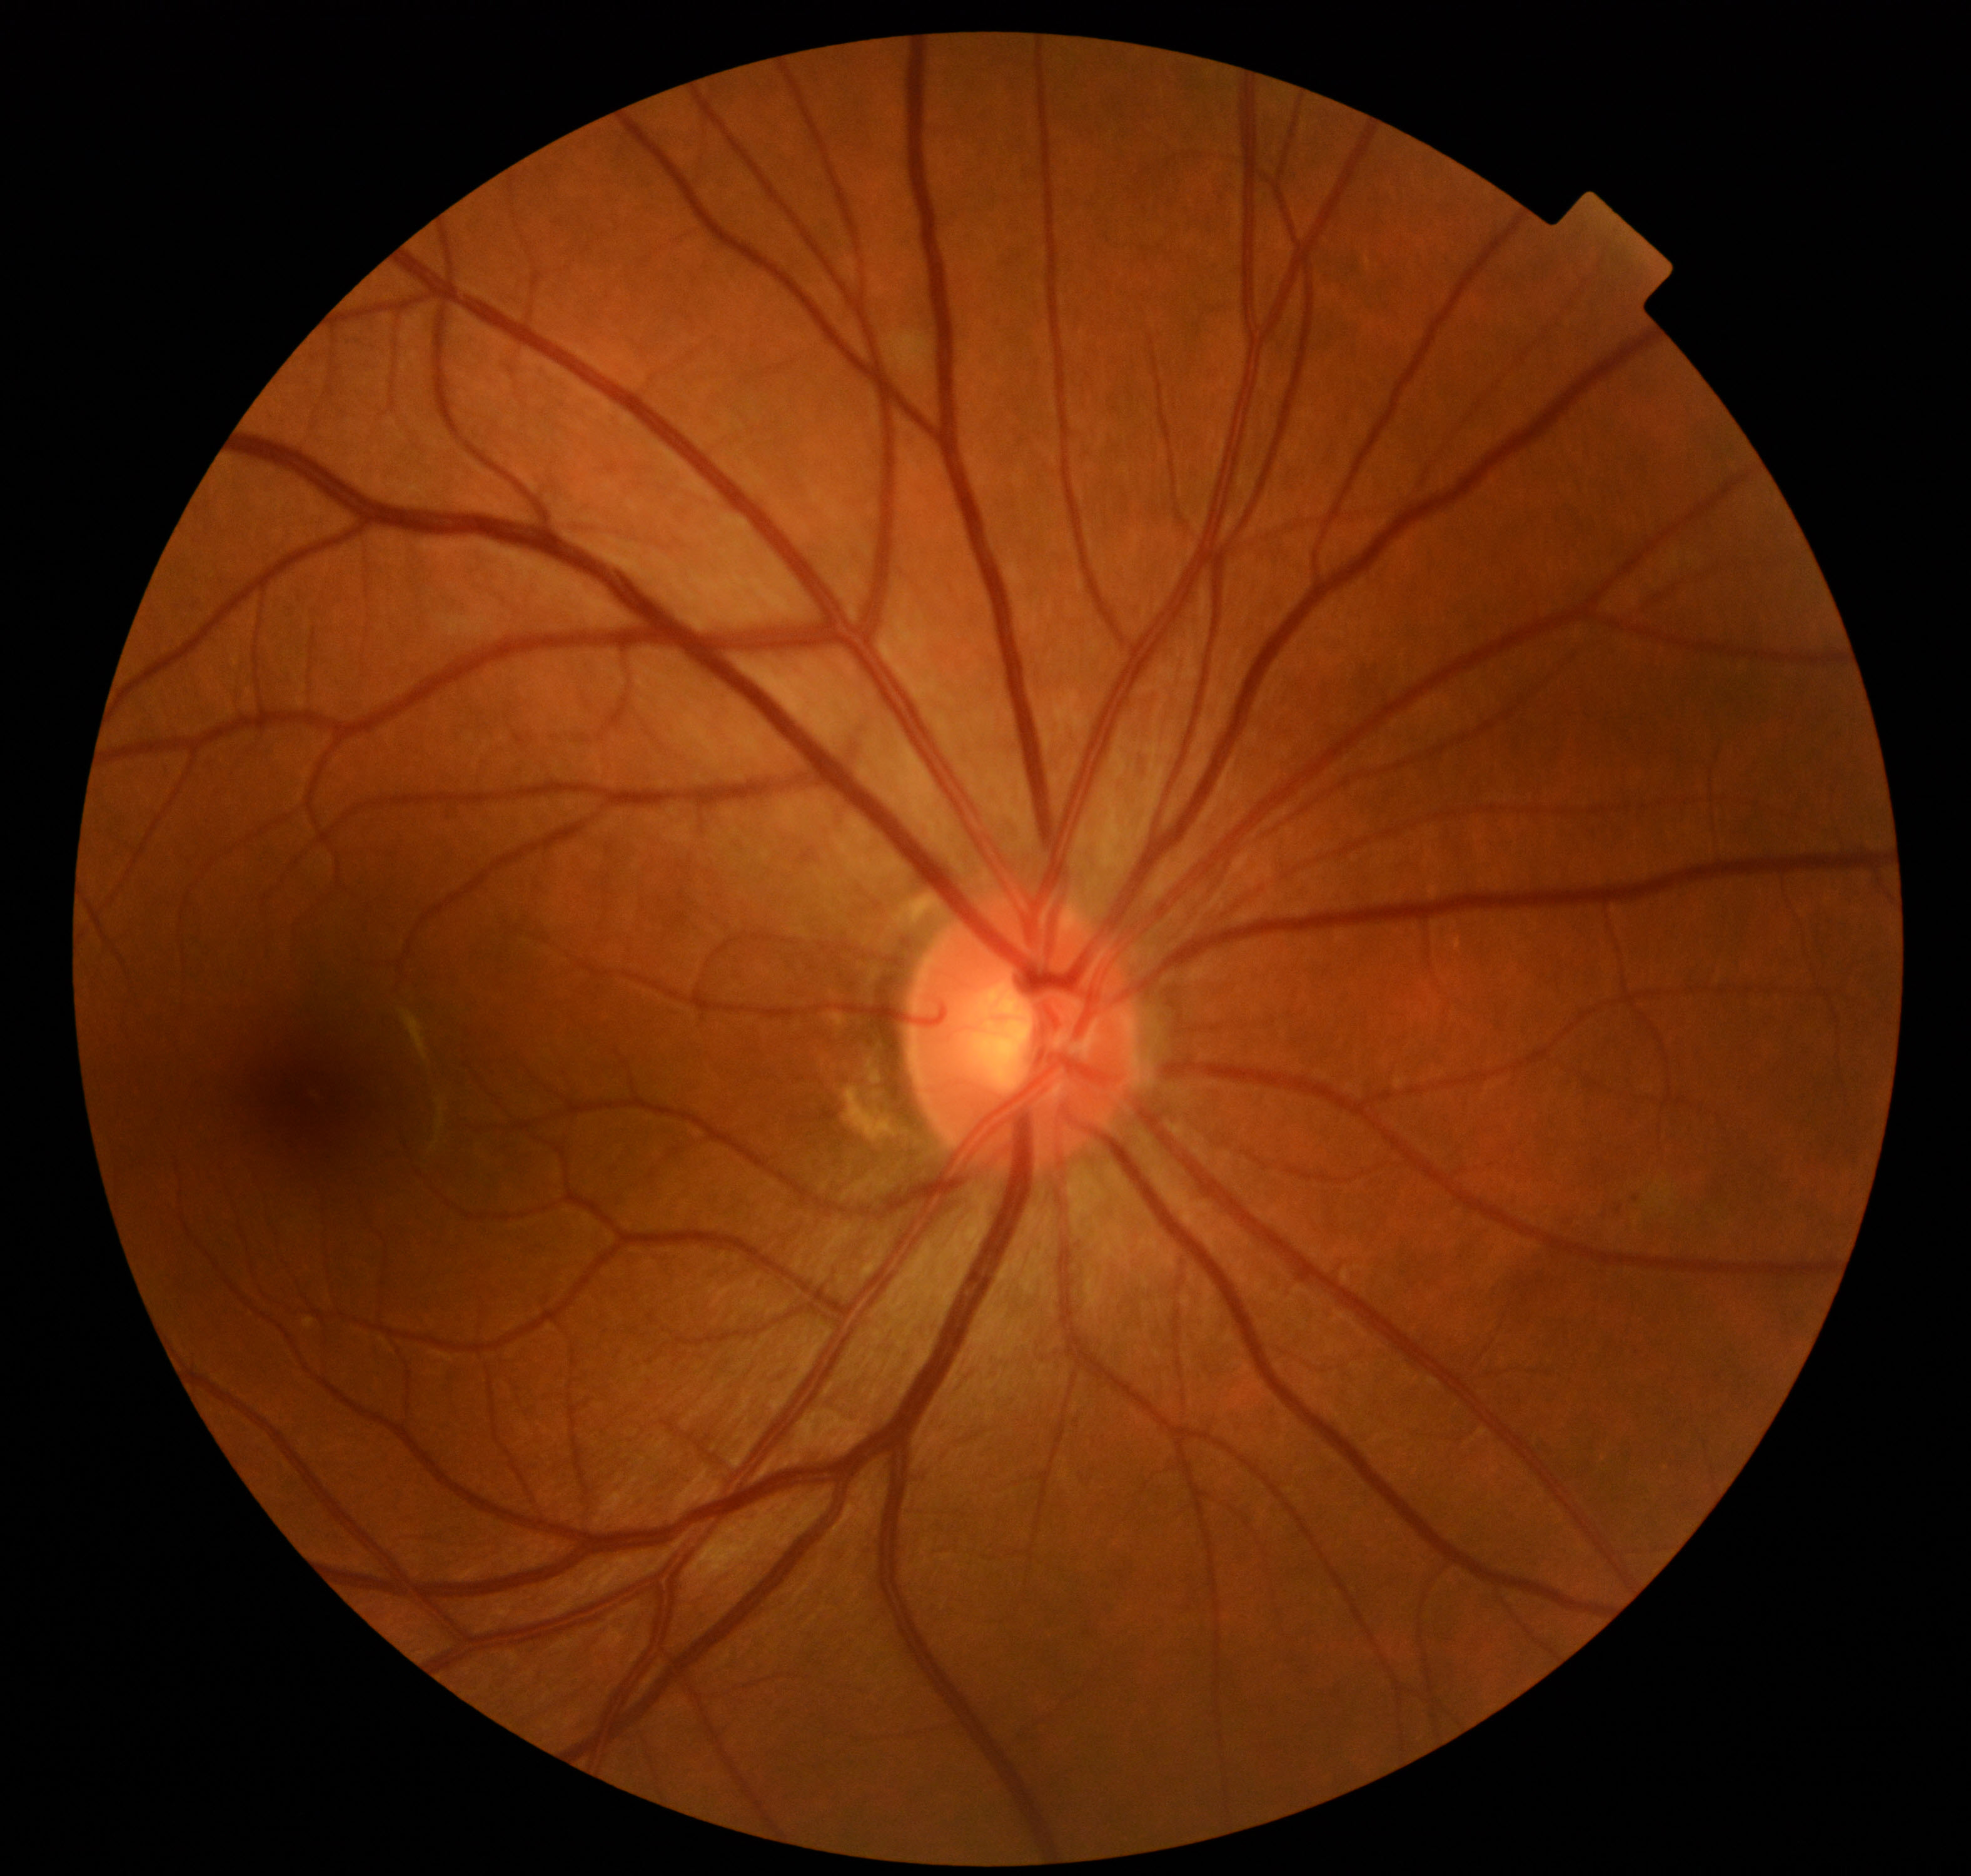
Color fundus photograph showing mild non-proliferative diabetic retinopathy. Characterized by microaneurysms only (International Classification of Diabetic Retinopathy, 2017).